Image size 1932x1910: 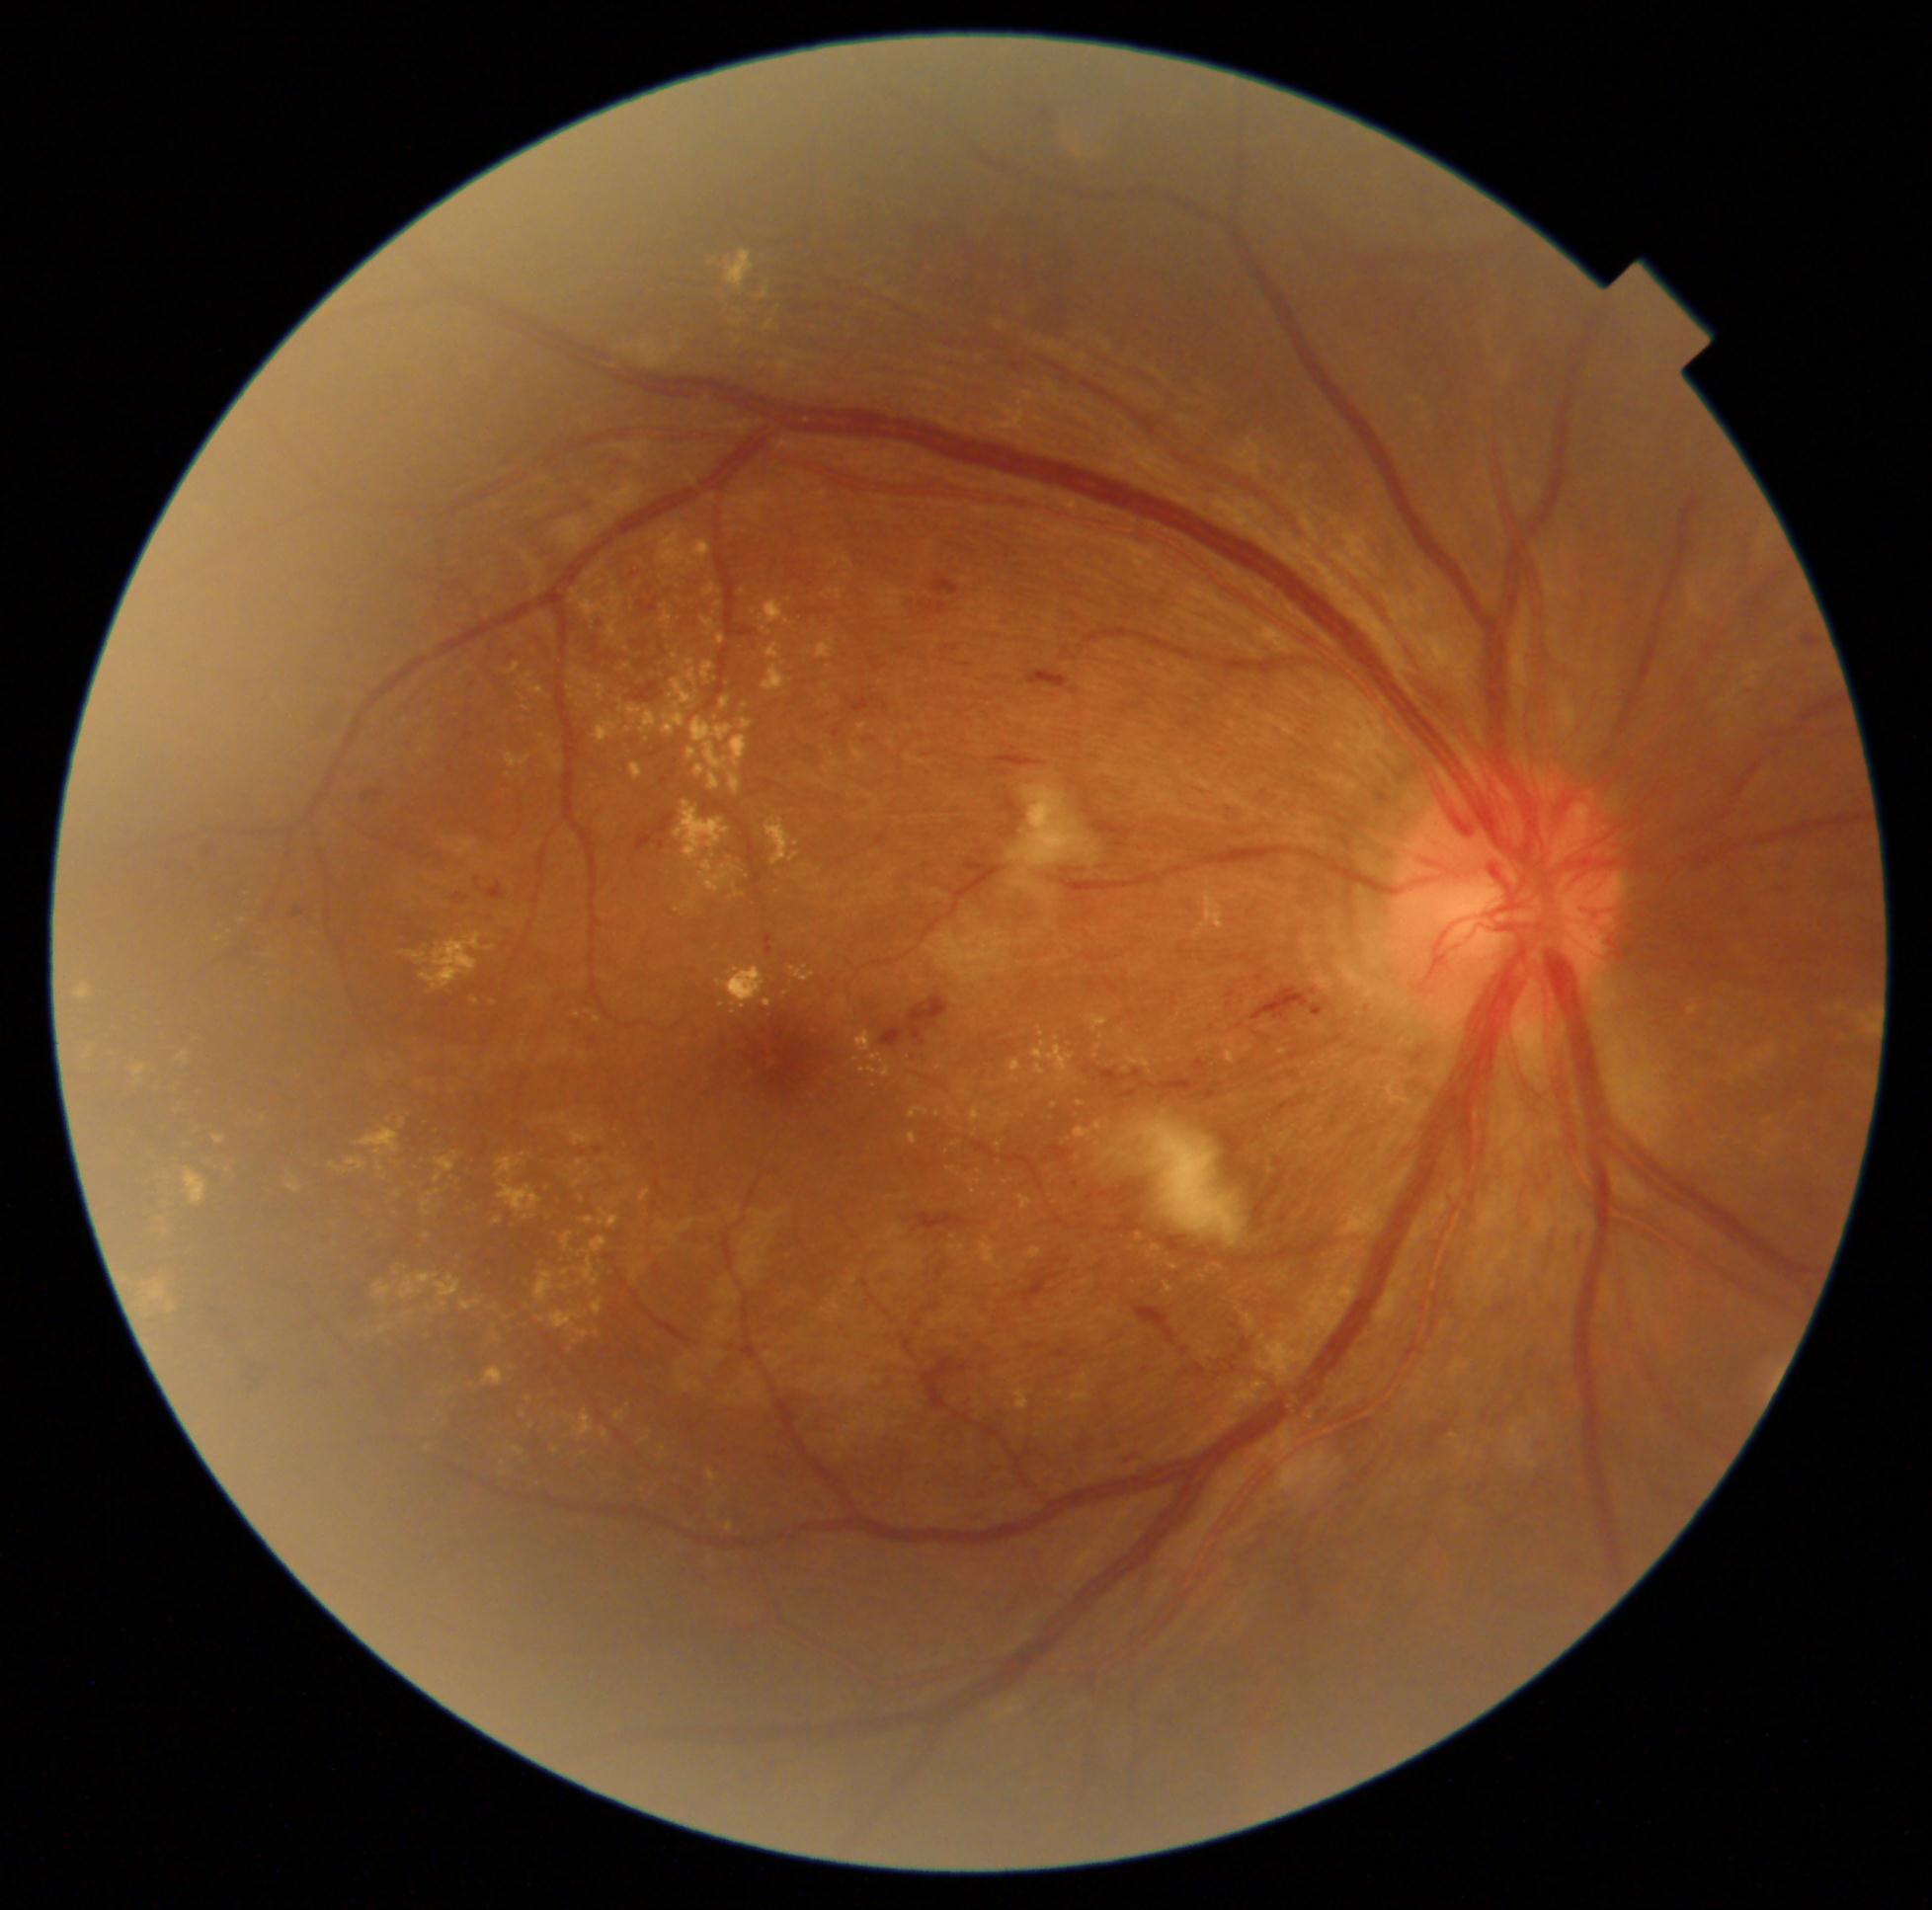
Retinopathy is grade 4 (PDR).